FOV: 45 degrees, 2048 by 1536 pixels, color fundus photograph
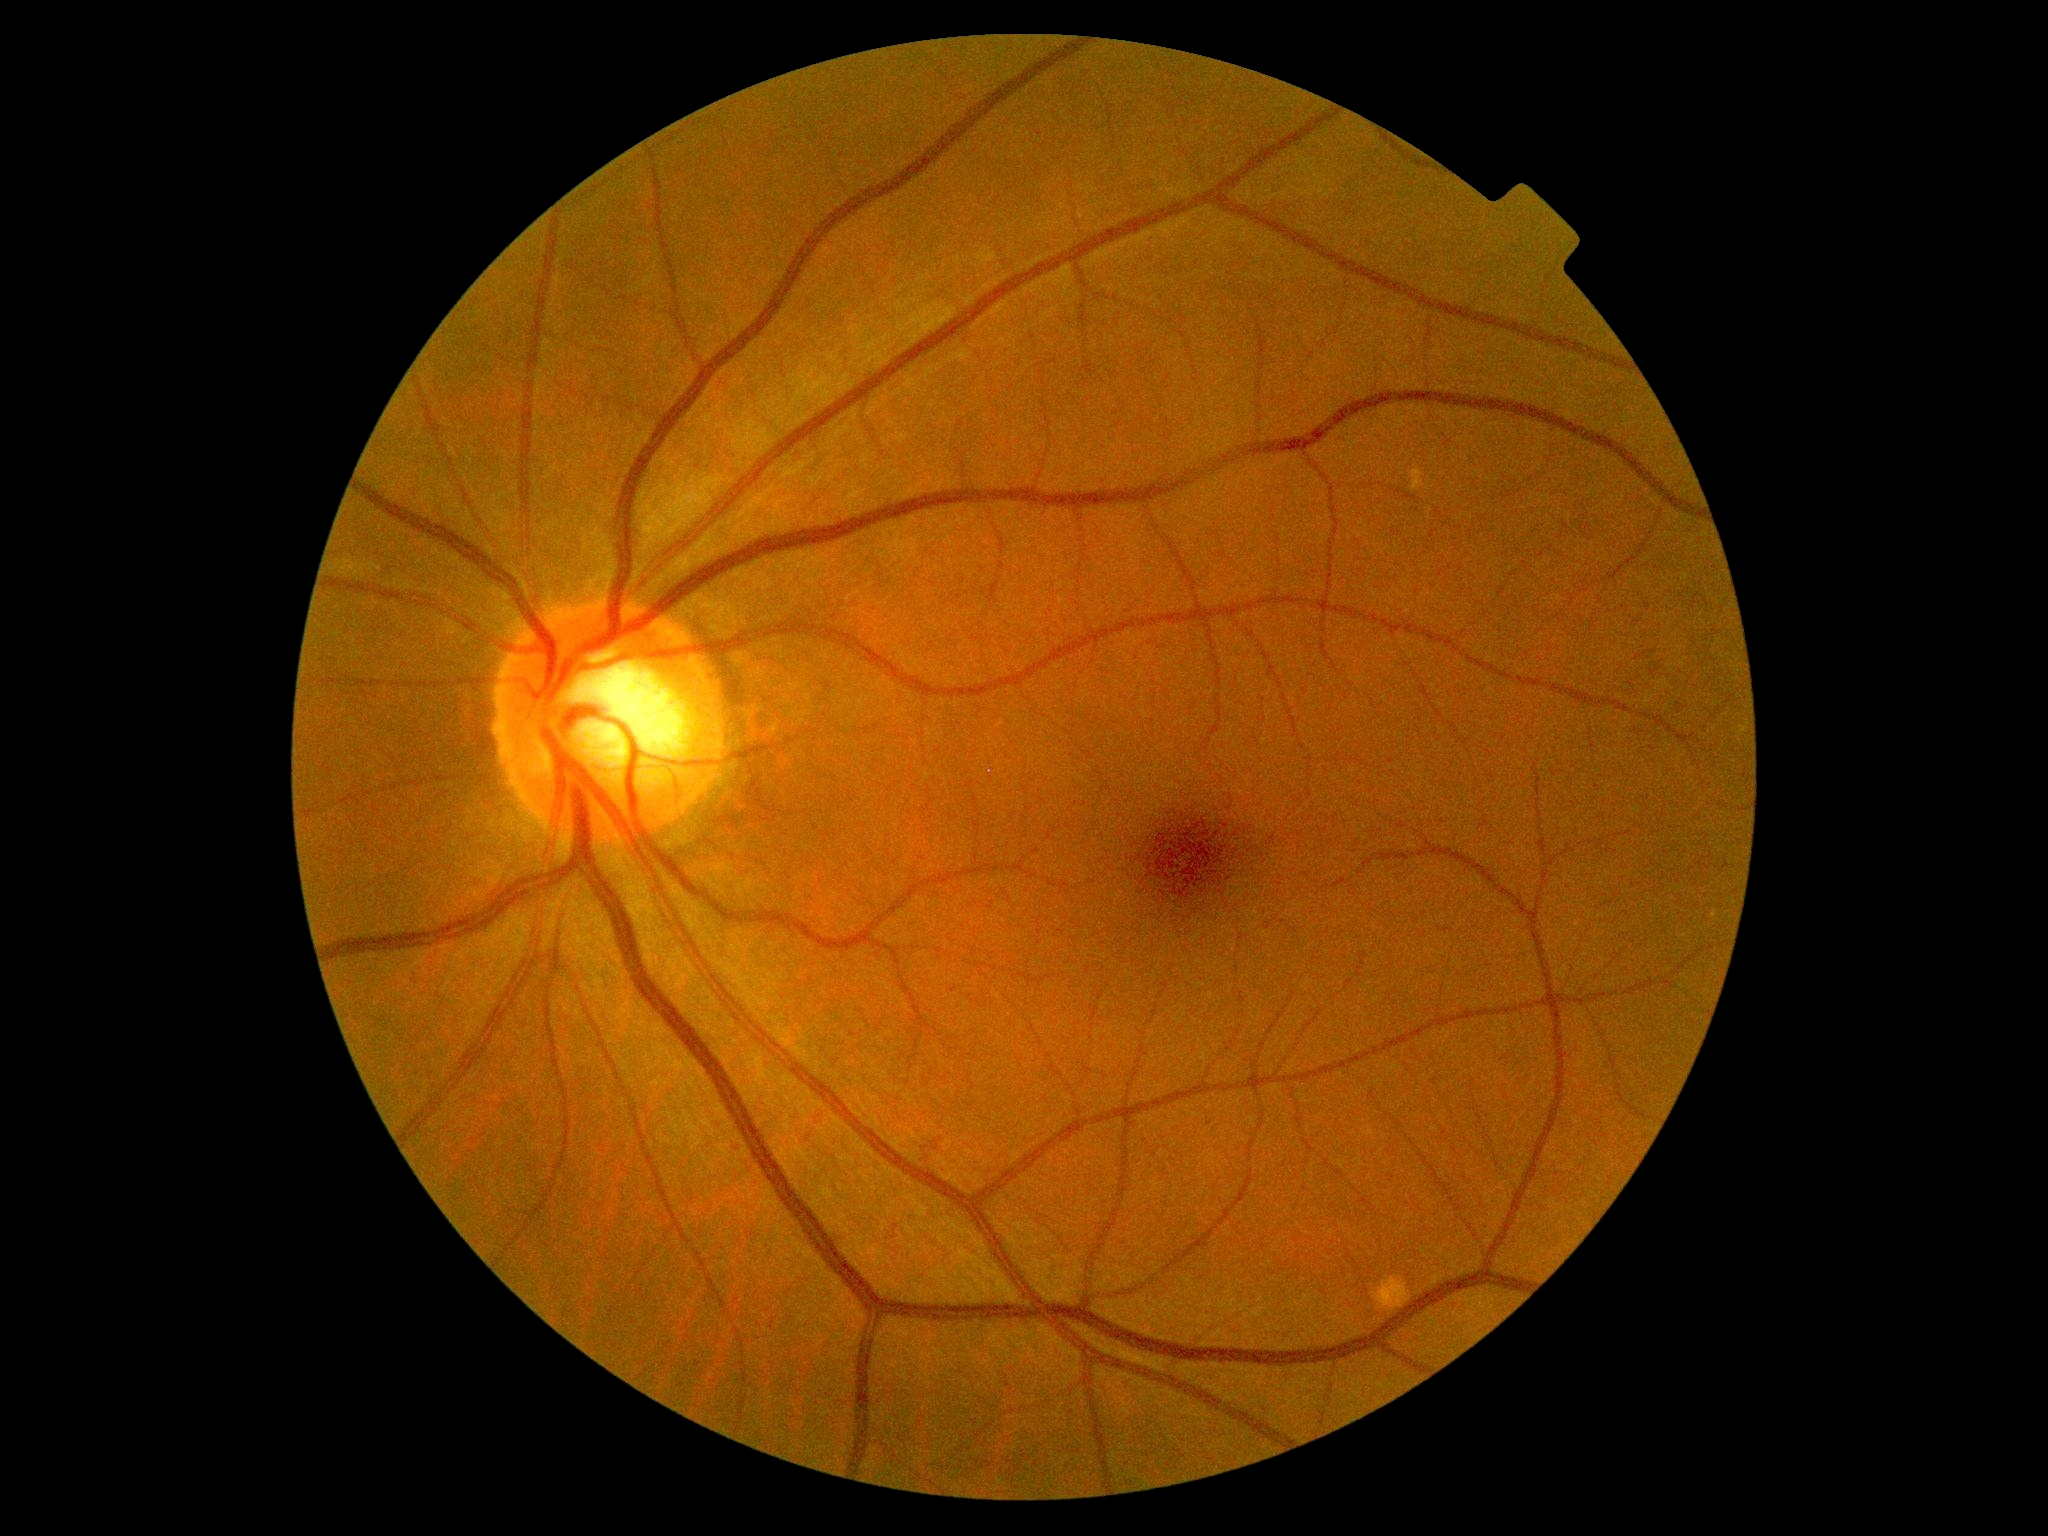
  dr_grade: 0/4